Optic disc region of a color fundus photo.
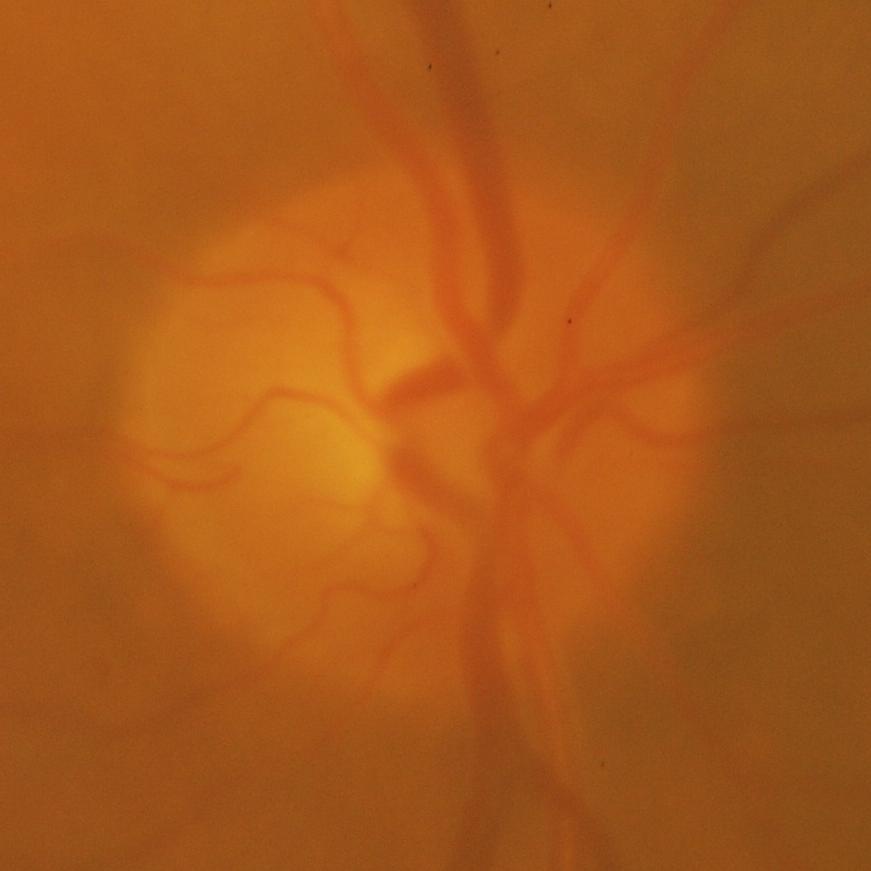
Glaucoma is present. Impression = glaucoma.